640x480px. Infant wide-field retinal image. 130° field of view (Clarity RetCam 3)
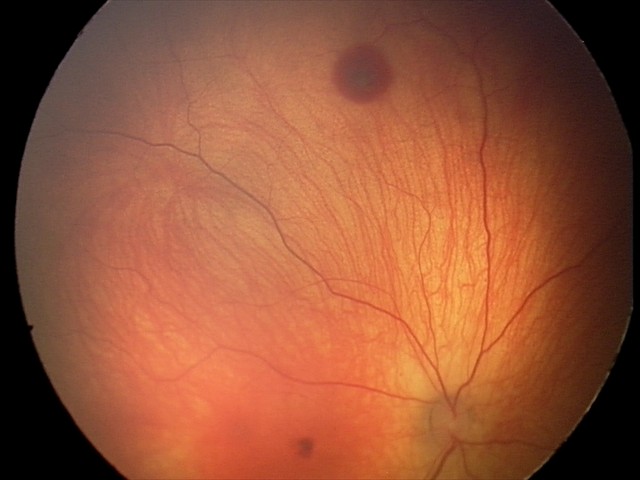
Diagnosis from this screening exam: retinal hemorrhages.